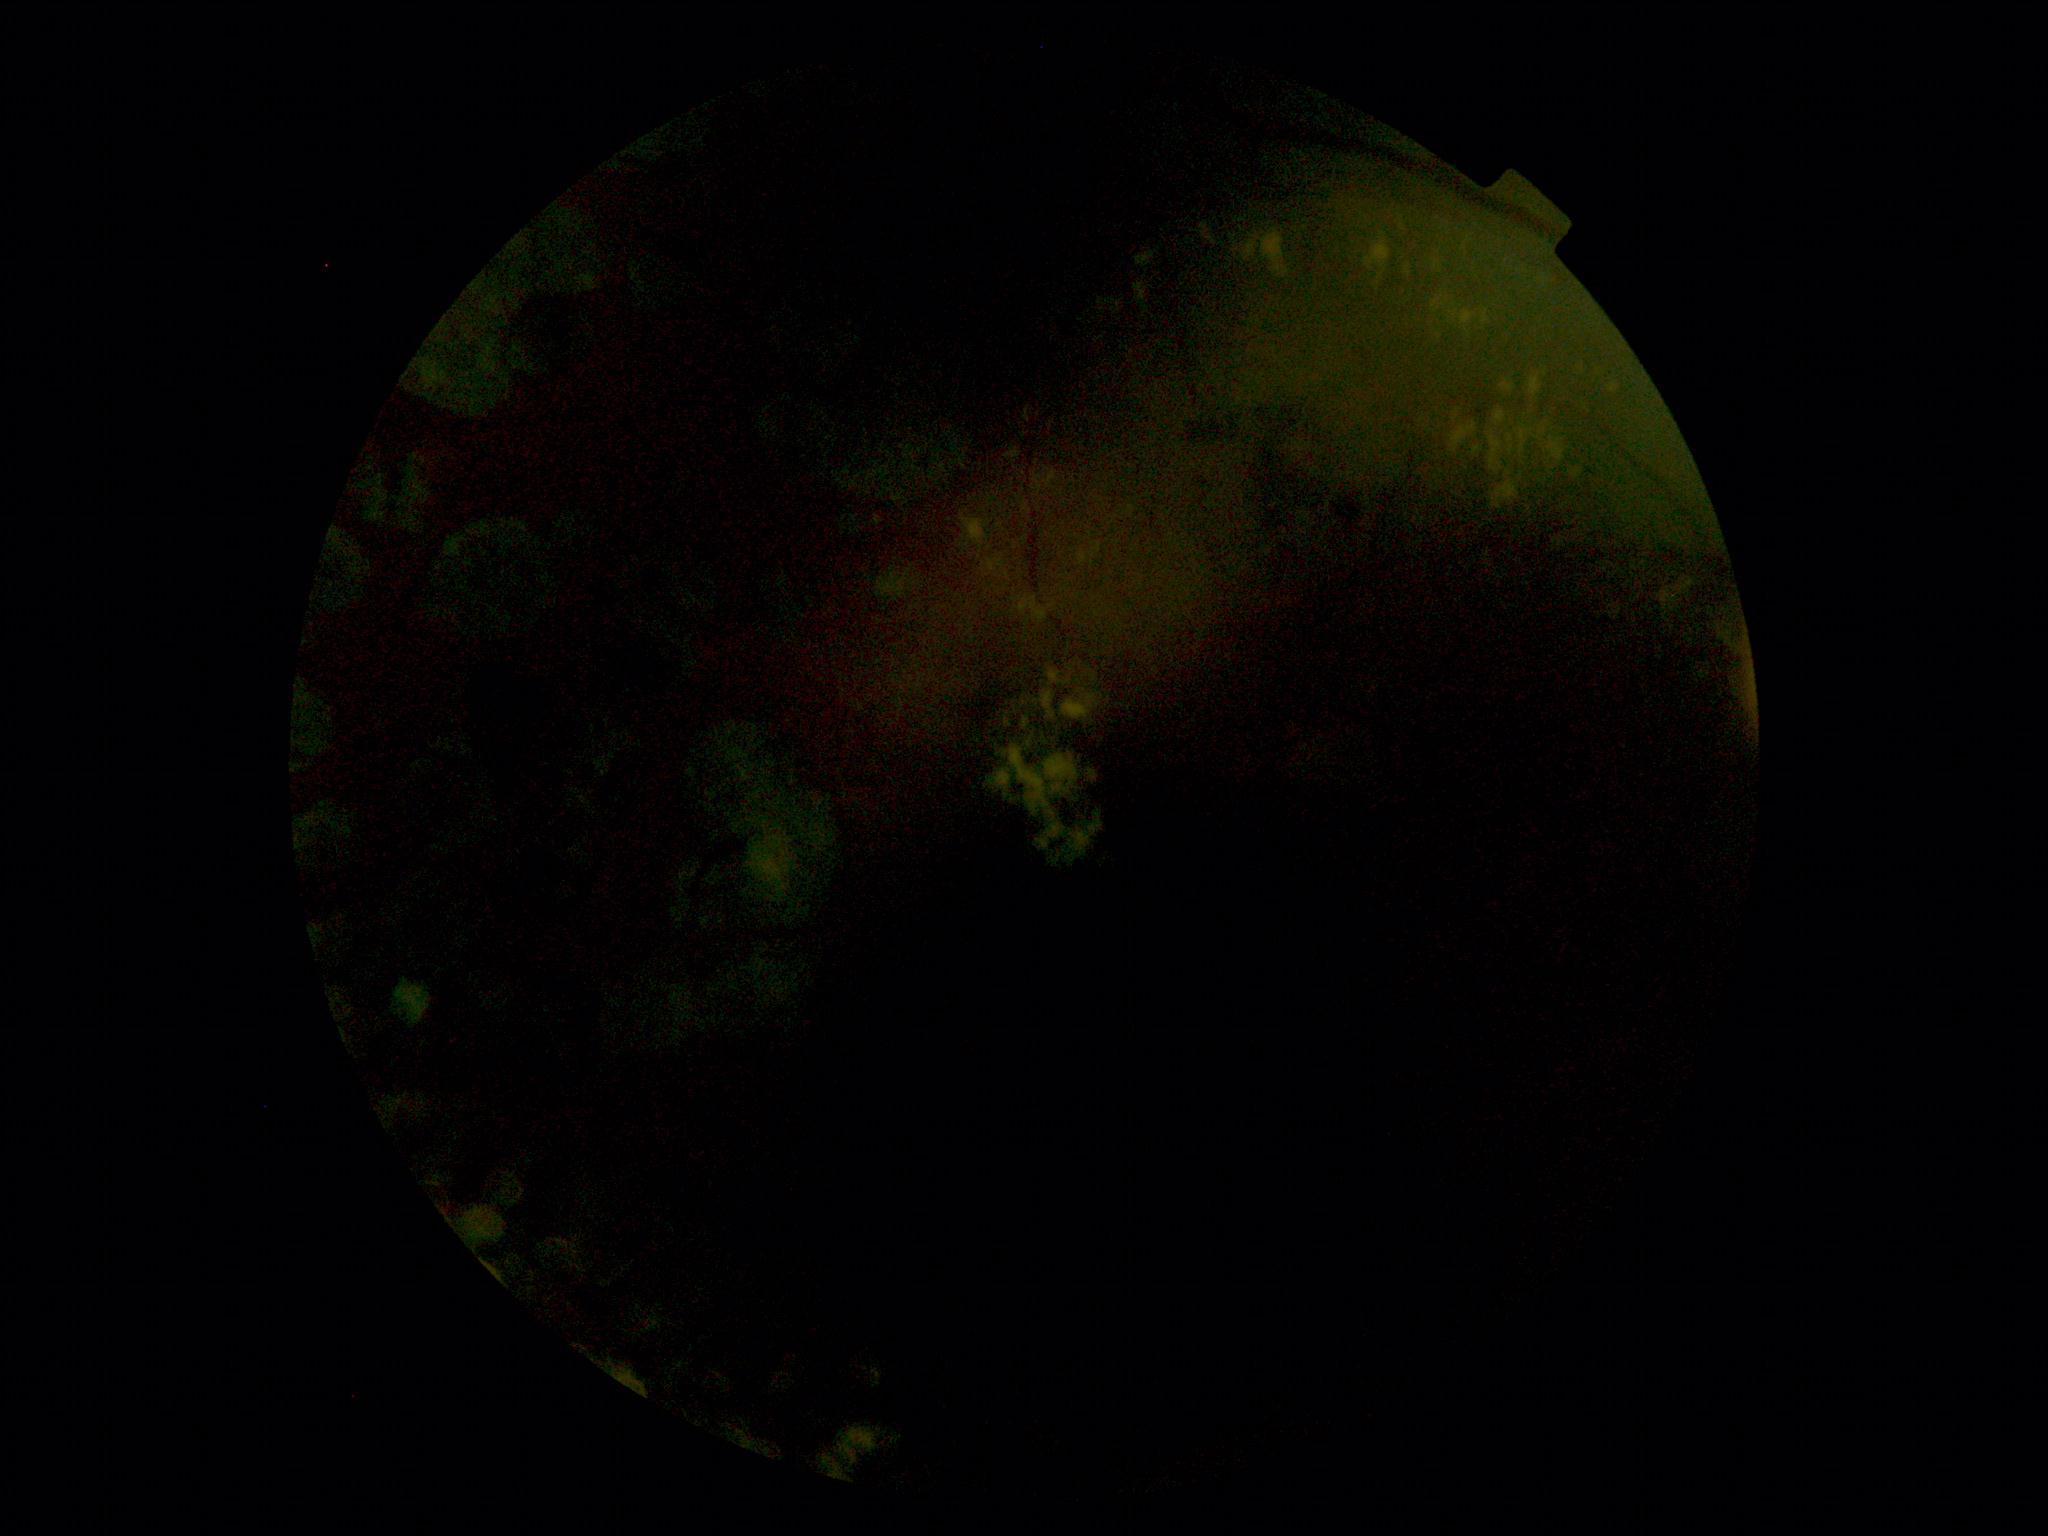 DR severity = grade 2 (moderate NPDR) | DR class = non-proliferative diabetic retinopathy.